Posterior pole color fundus photograph. Graded on the modified Davis scale:
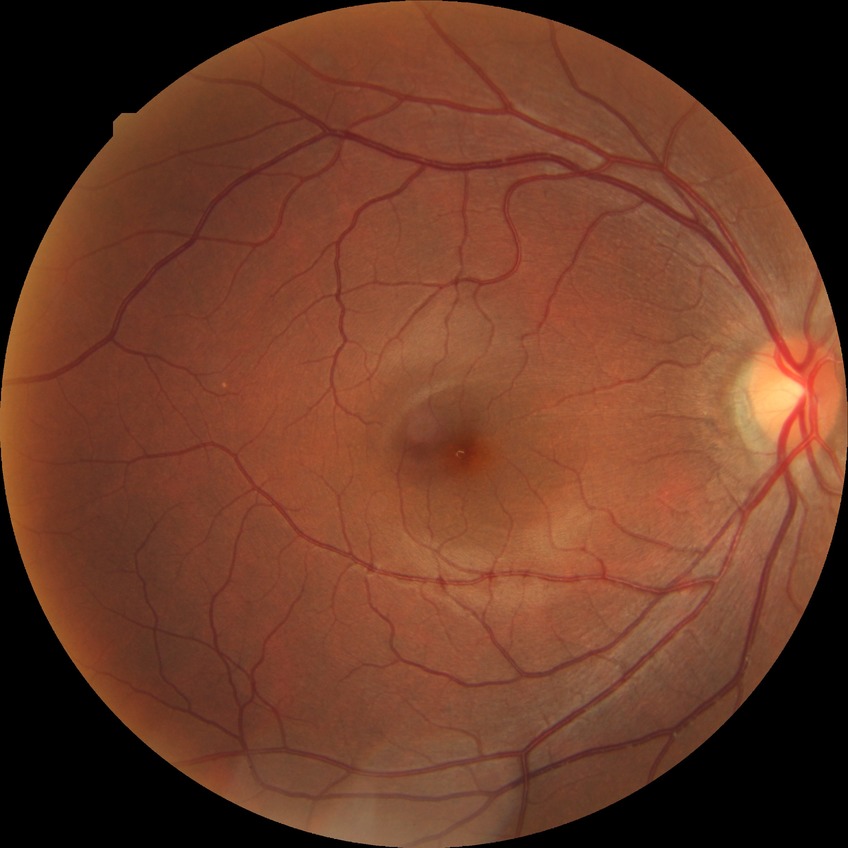
Davis grade is NDR.